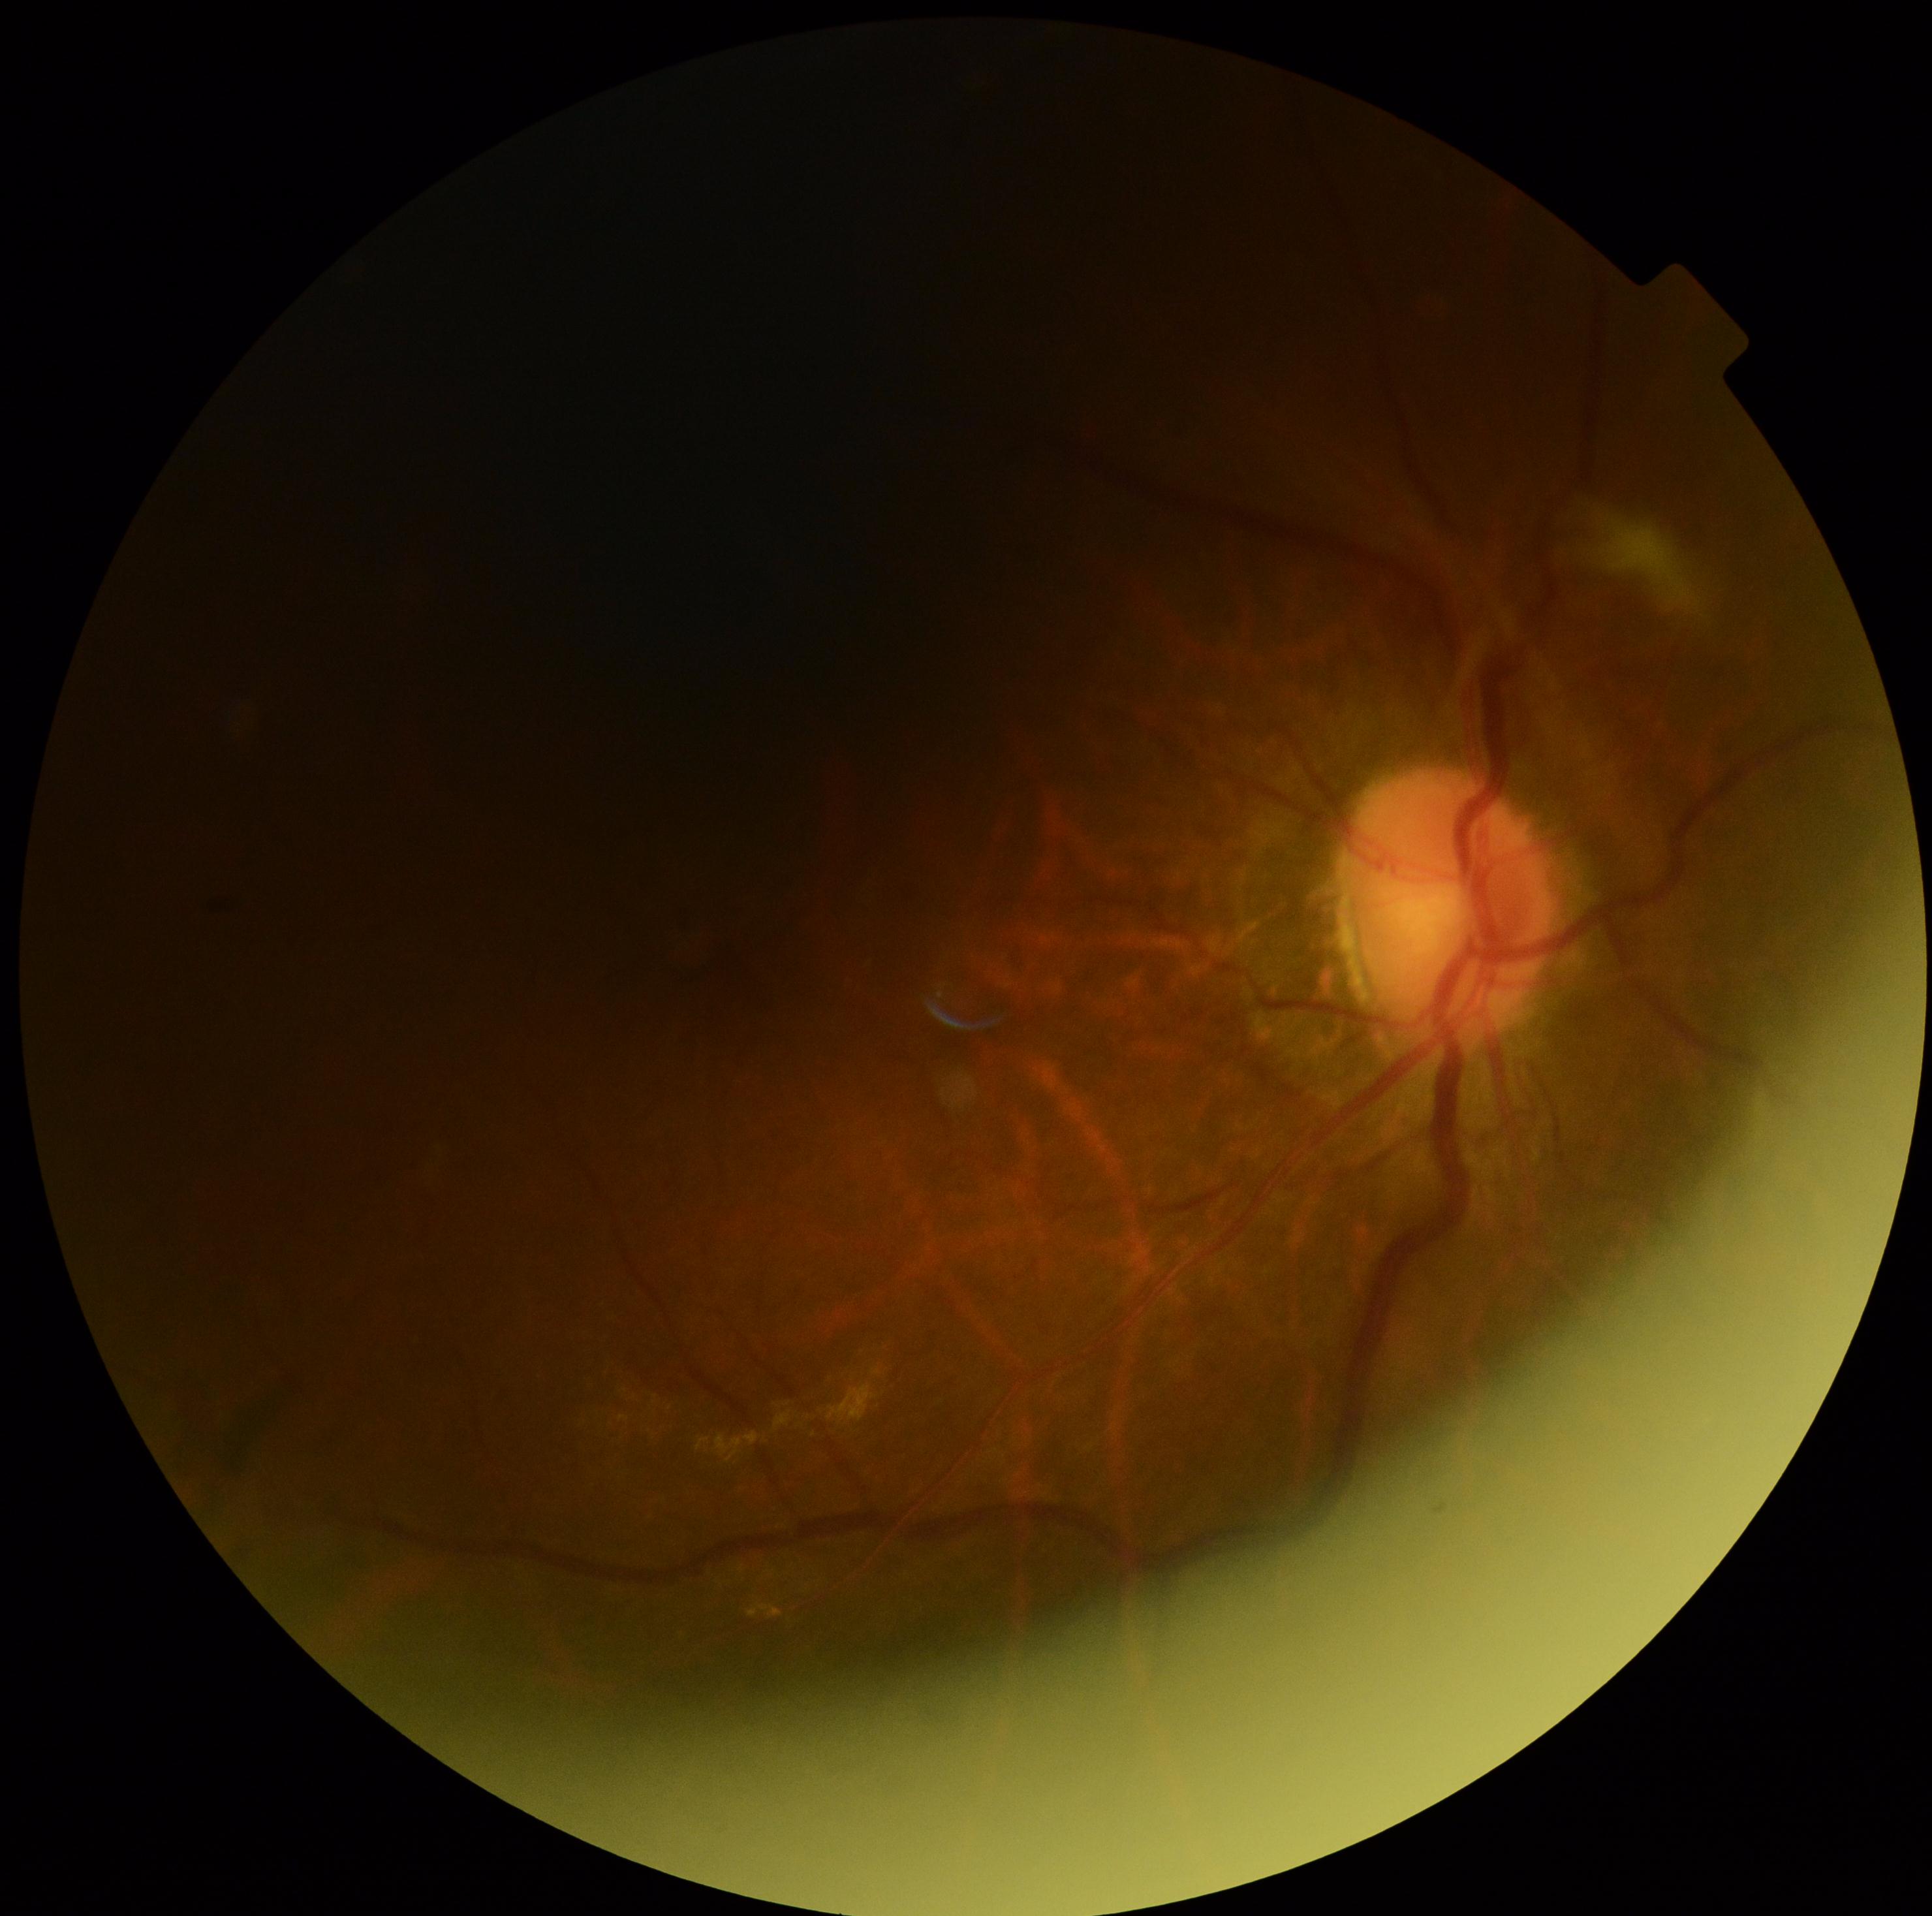

DR severity is 2/4.